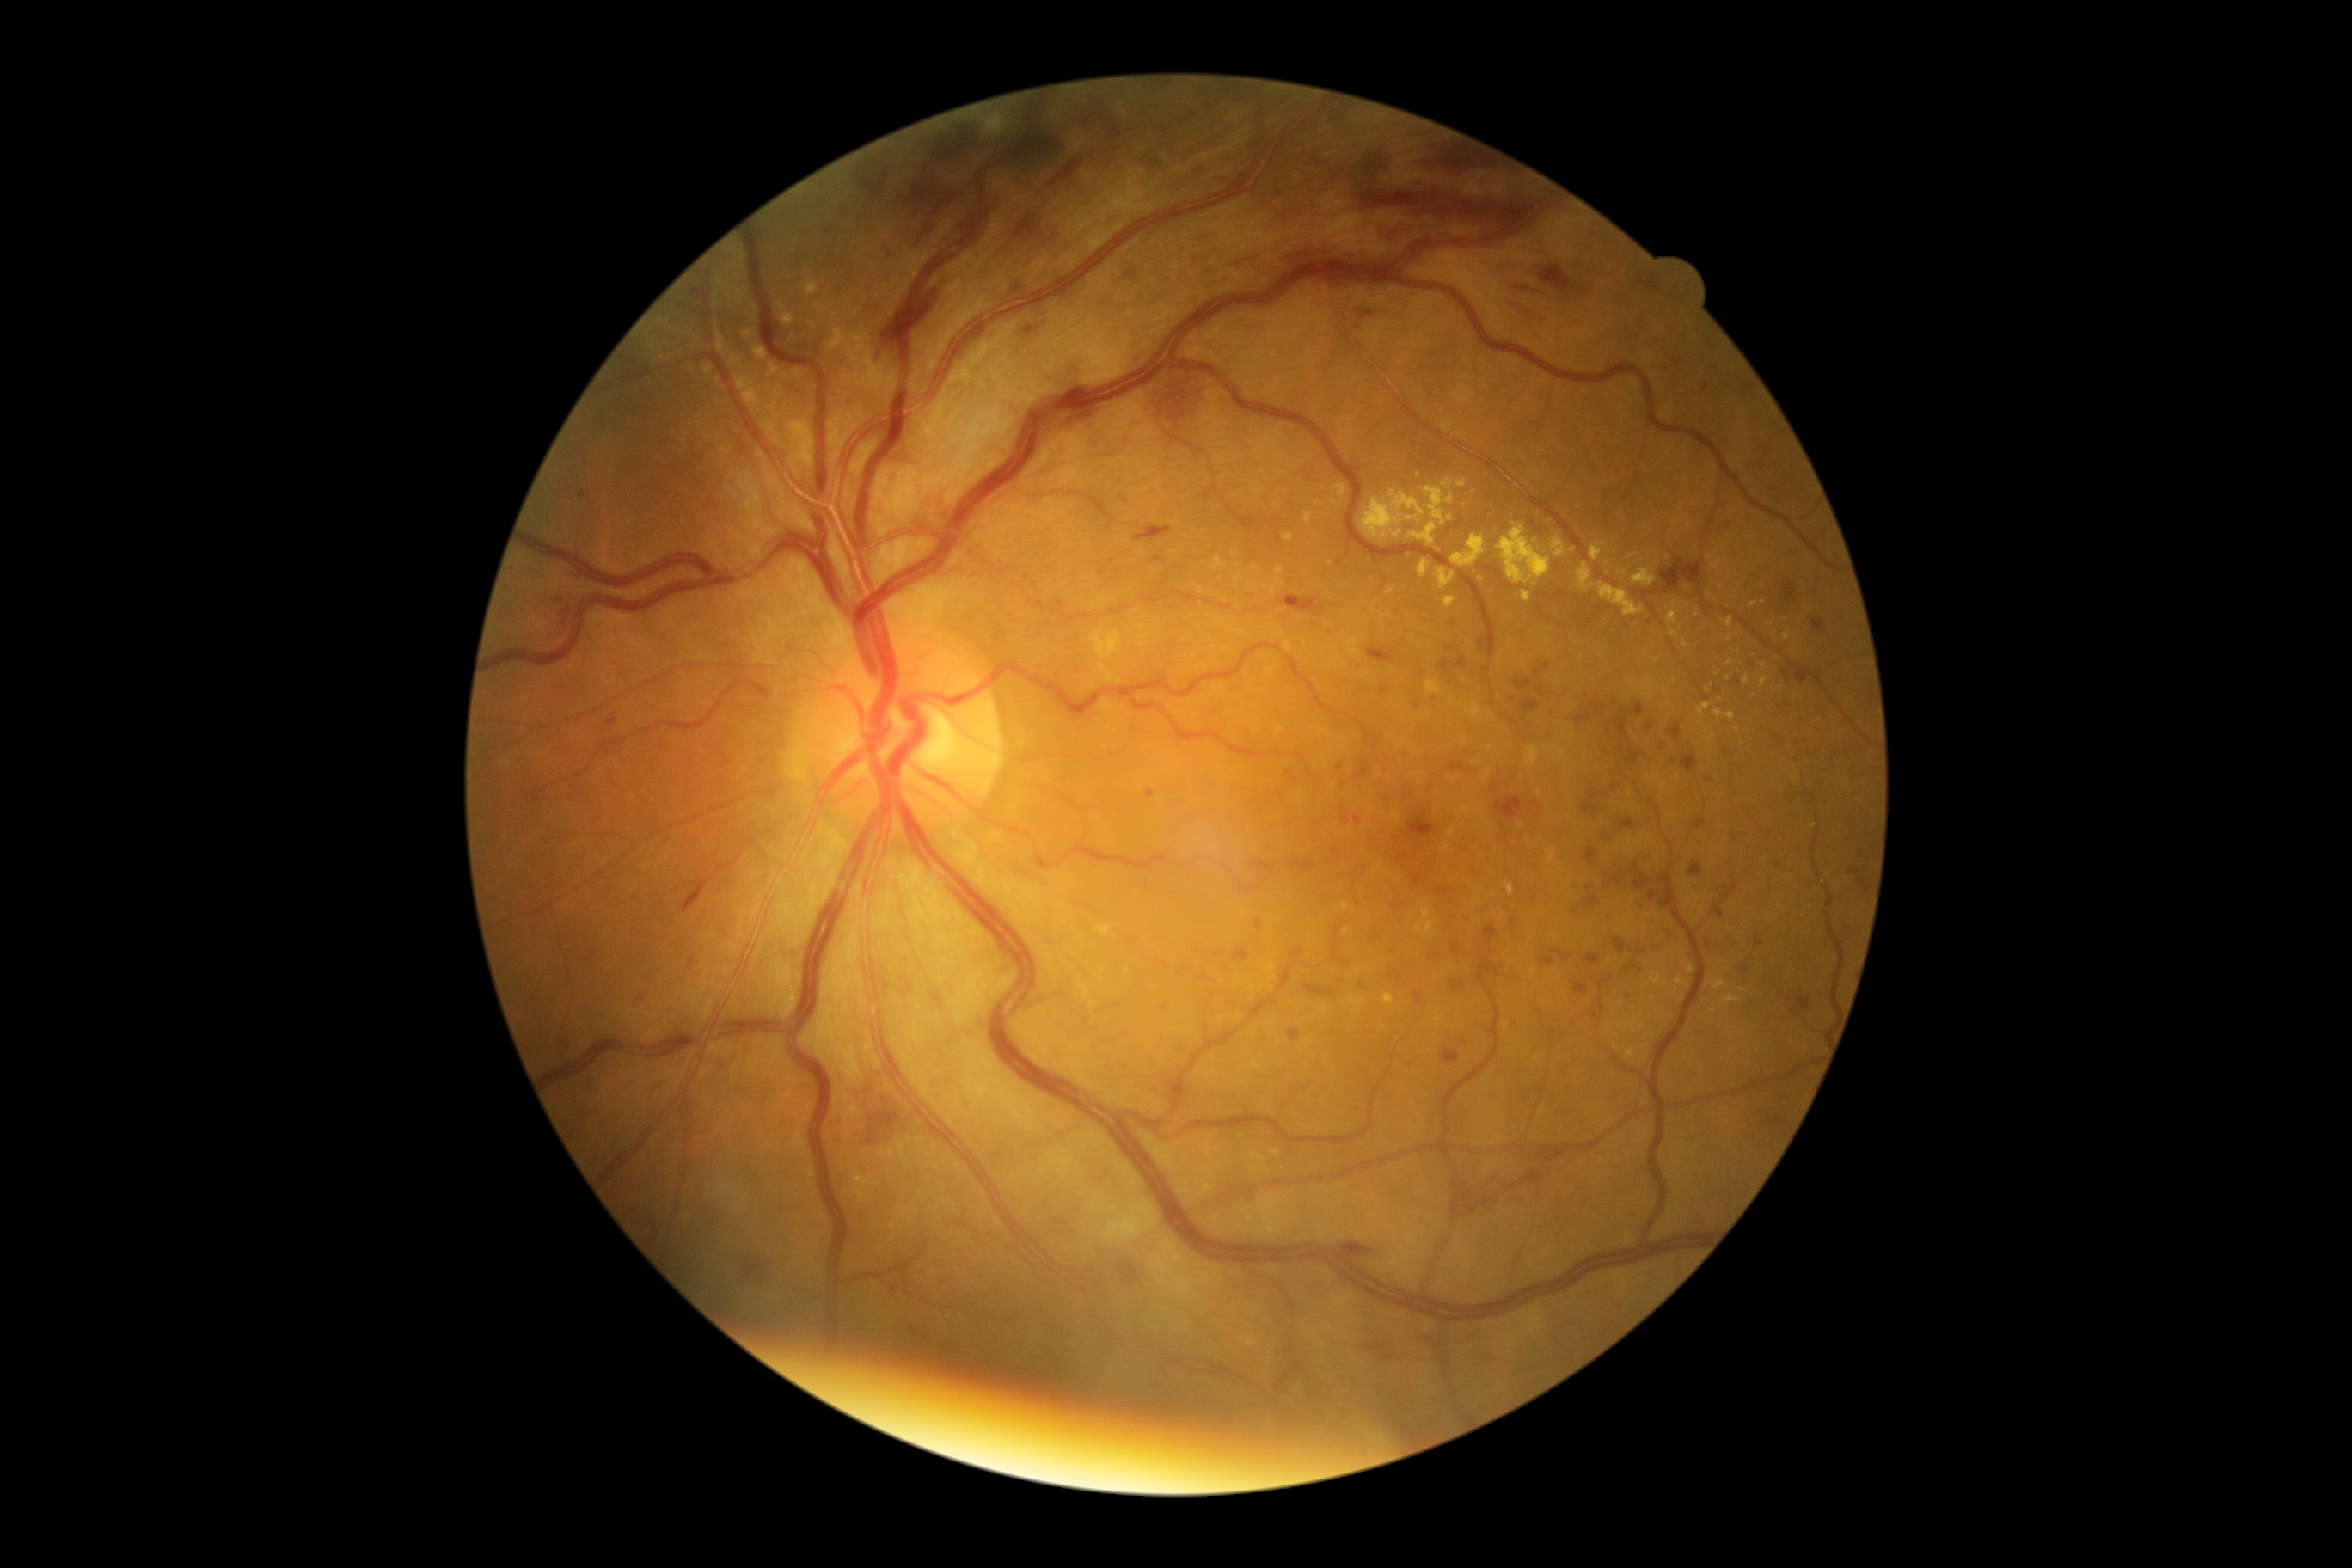 Retinopathy grade: 3 — more than 20 intraretinal hemorrhages in each of 4 quadrants, definite venous beading in 2 or more quadrants, or prominent intraretinal microvascular abnormalities in 1 or more quadrants, with no signs of proliferative retinopathy.